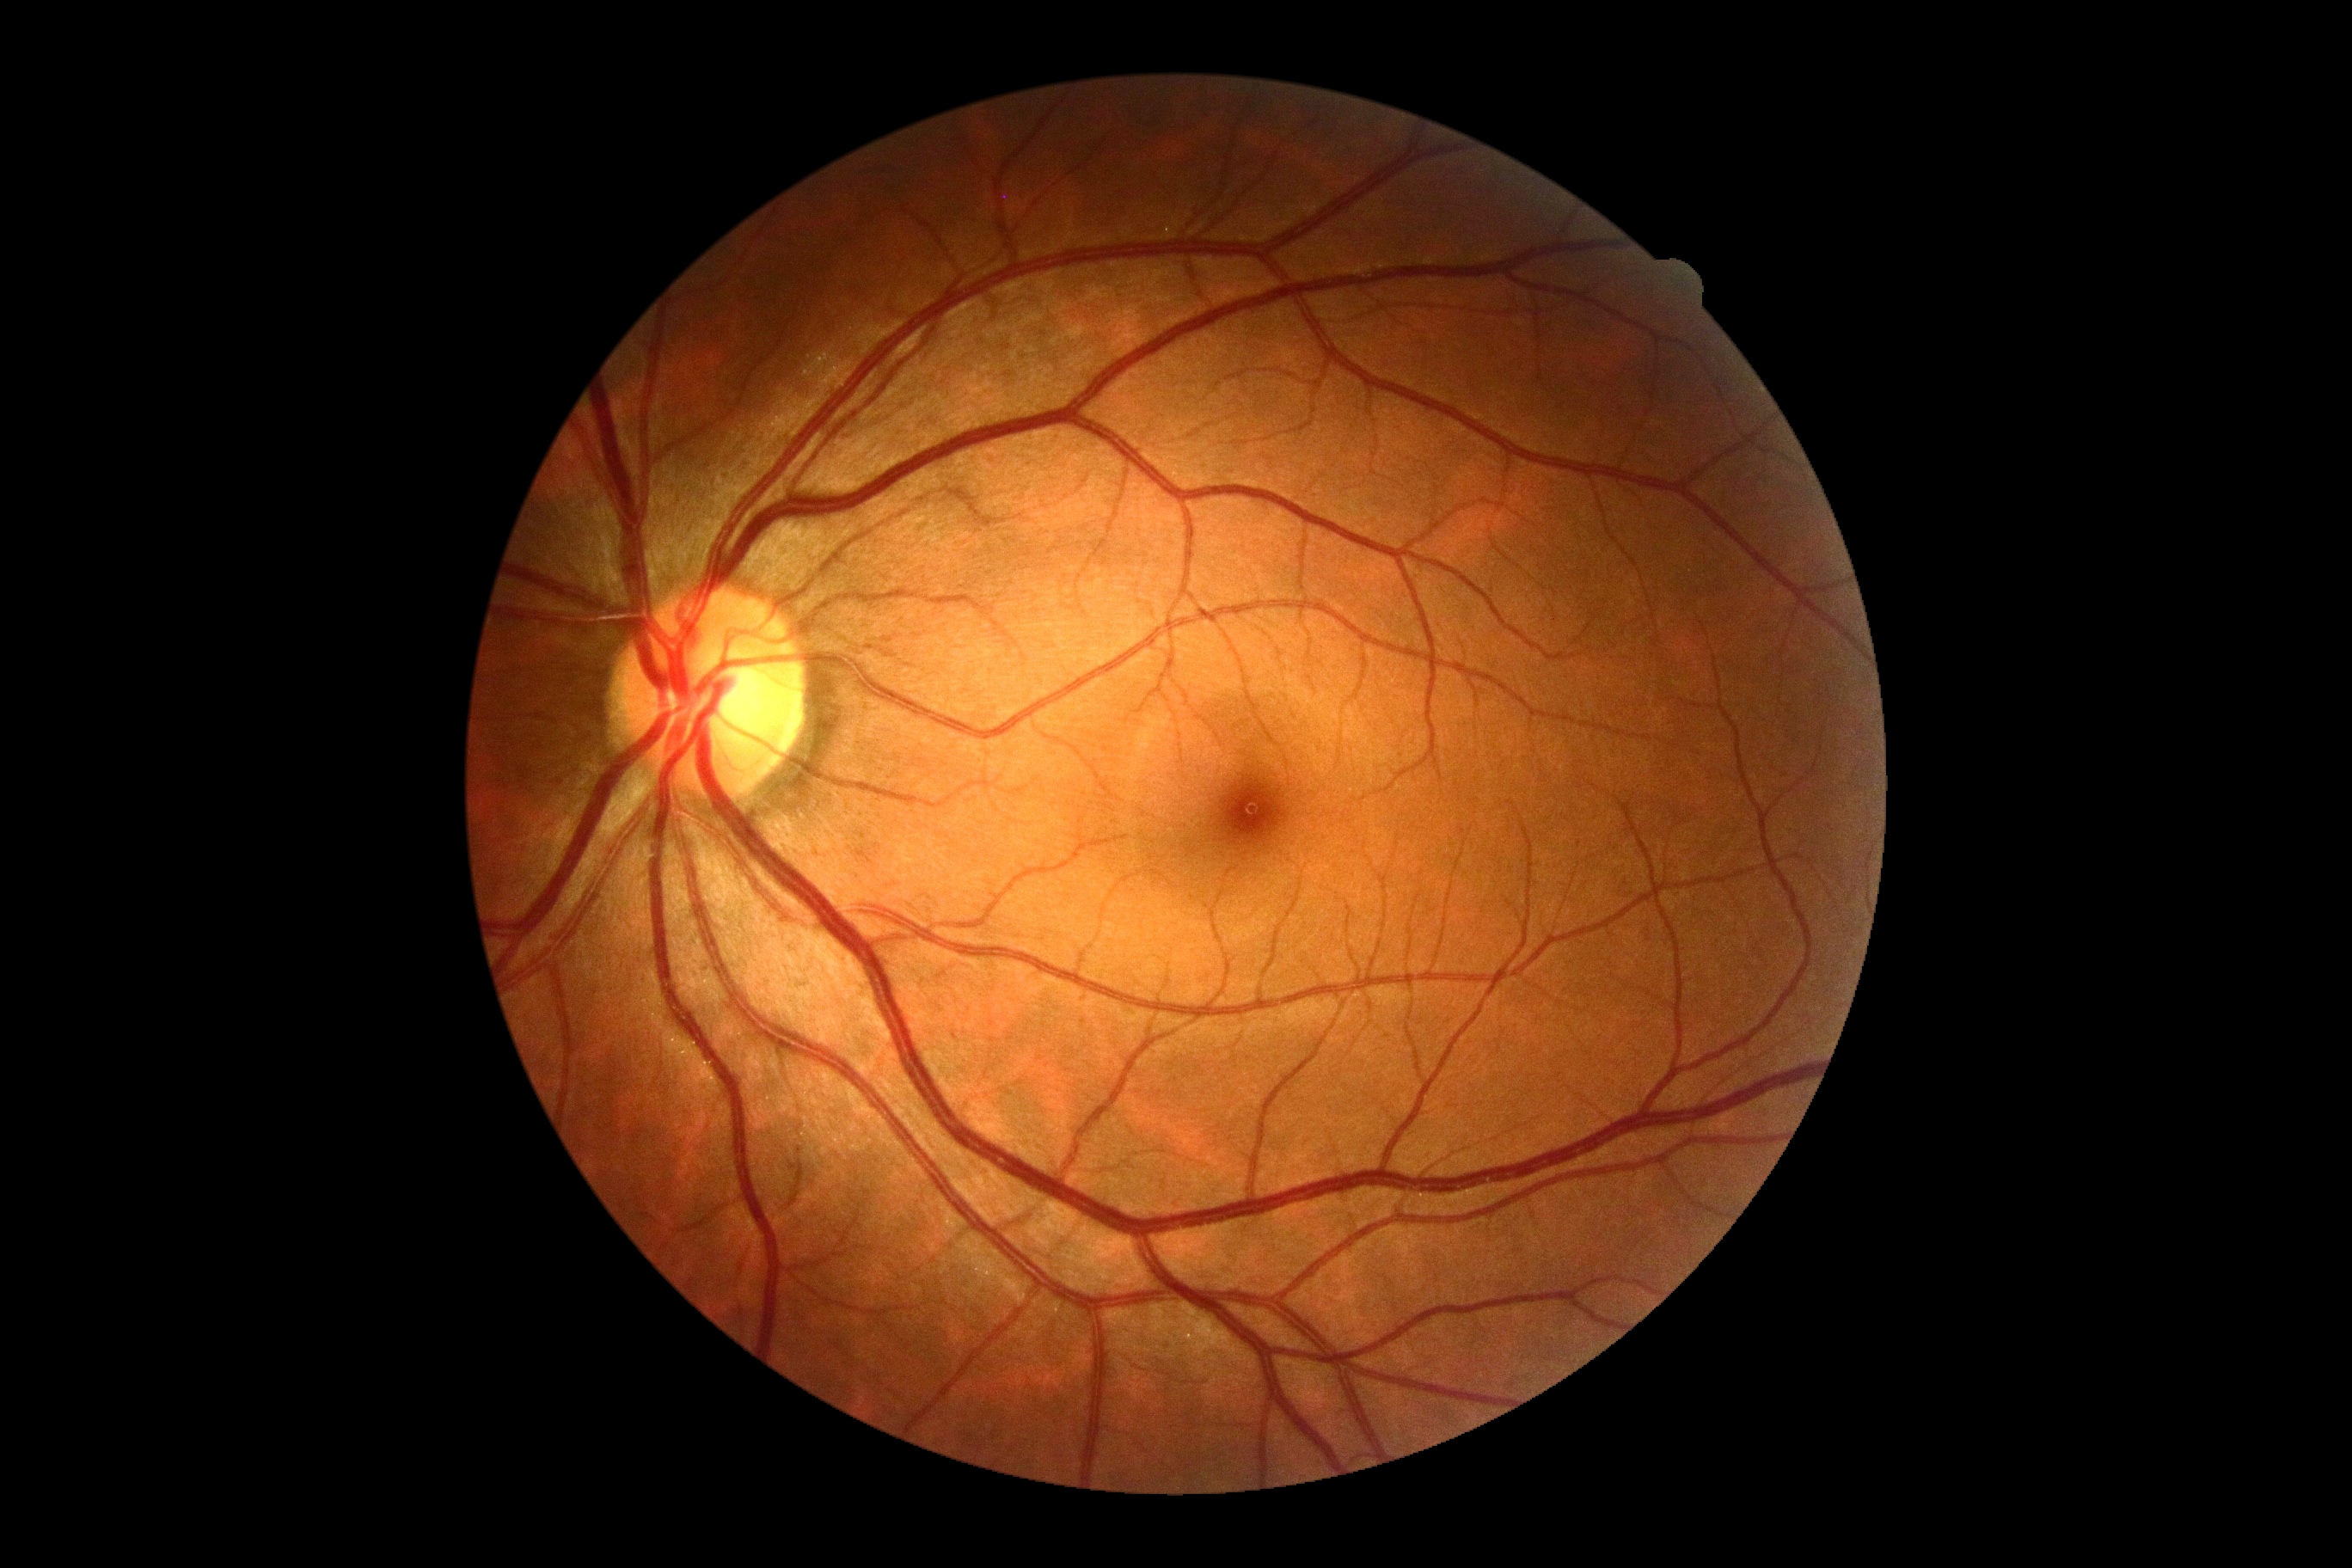 {
  "dr_grade": "grade 0 (no apparent retinopathy)",
  "dr_impression": "no apparent DR"
}